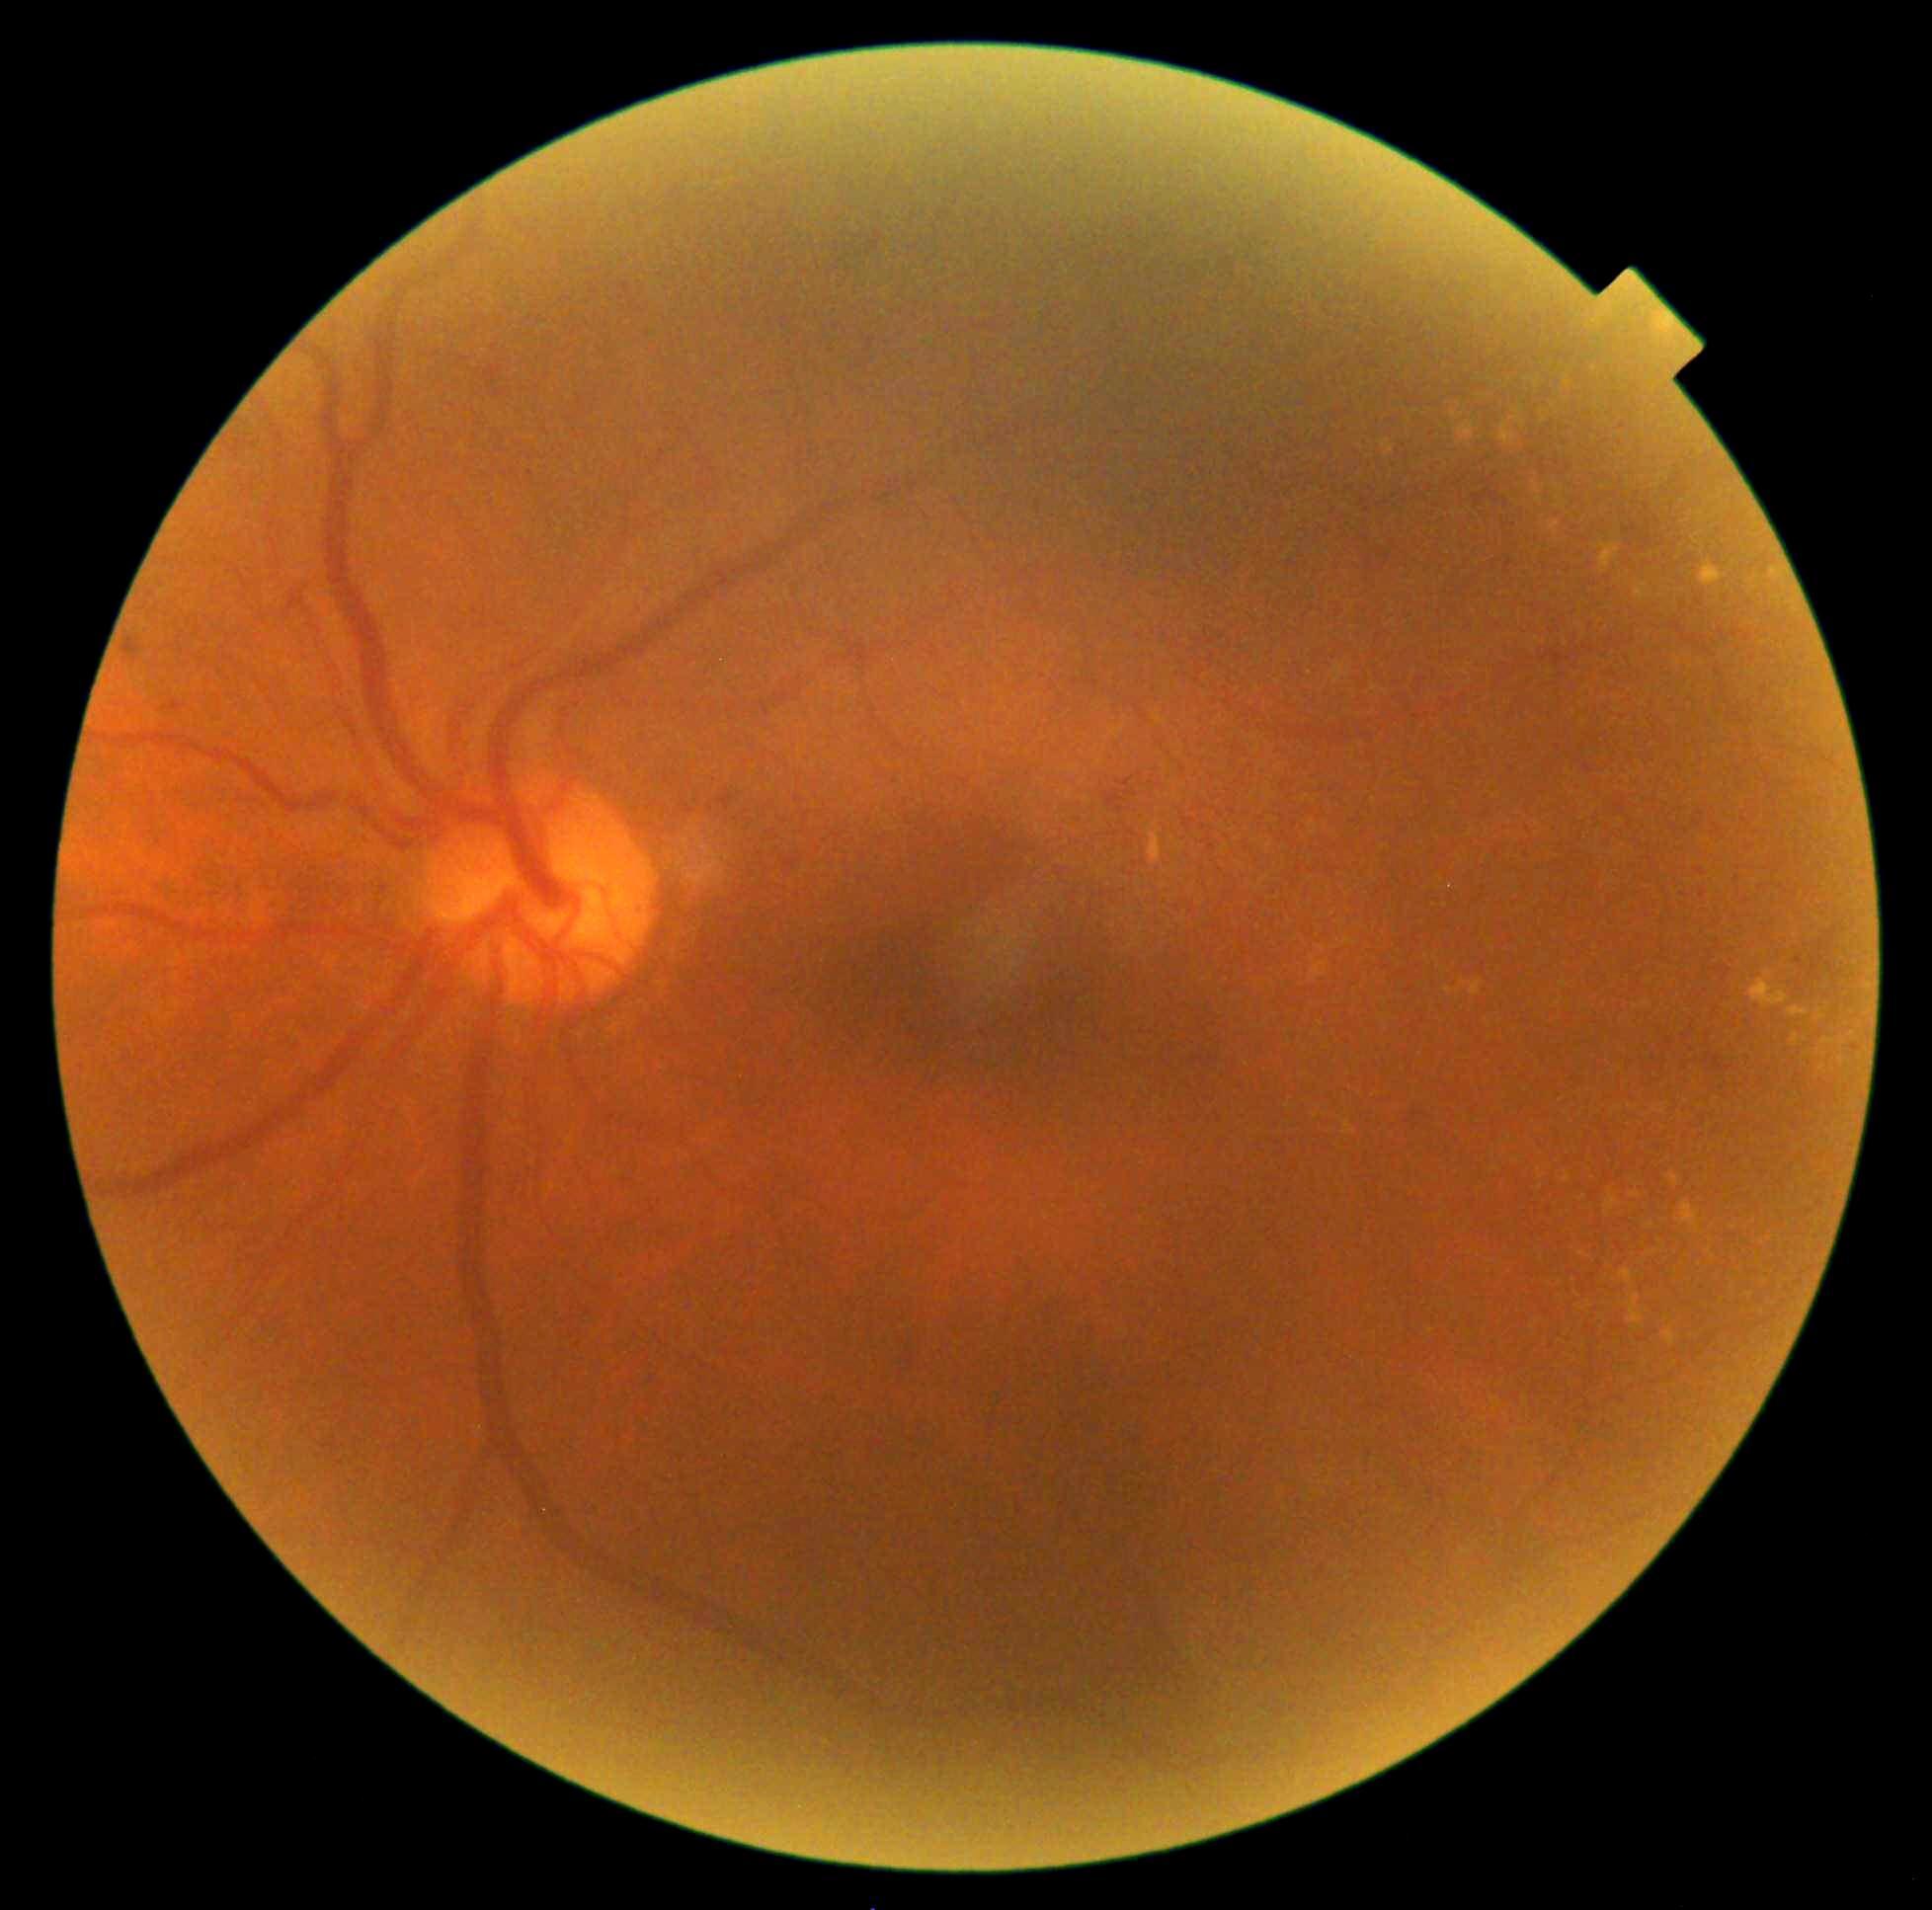 DR severity is grade 2.
EXs include lesions at [1491,1167,1499,1173] | [1700,562,1727,587] | [1577,1307,1585,1311] | [1511,406,1526,428] | [1630,1191,1641,1198] | [1451,412,1464,421] | [1149,823,1163,865] | [1635,583,1648,601] | [1665,1328,1676,1346] | [1766,971,1773,980].
Smaller EXs around (1458, 992) | (1582, 1254) | (1733, 1229) | (1589, 1306) | (1509, 1139).